Ultra-widefield (UWF) fundus image; 200-degree field of view.
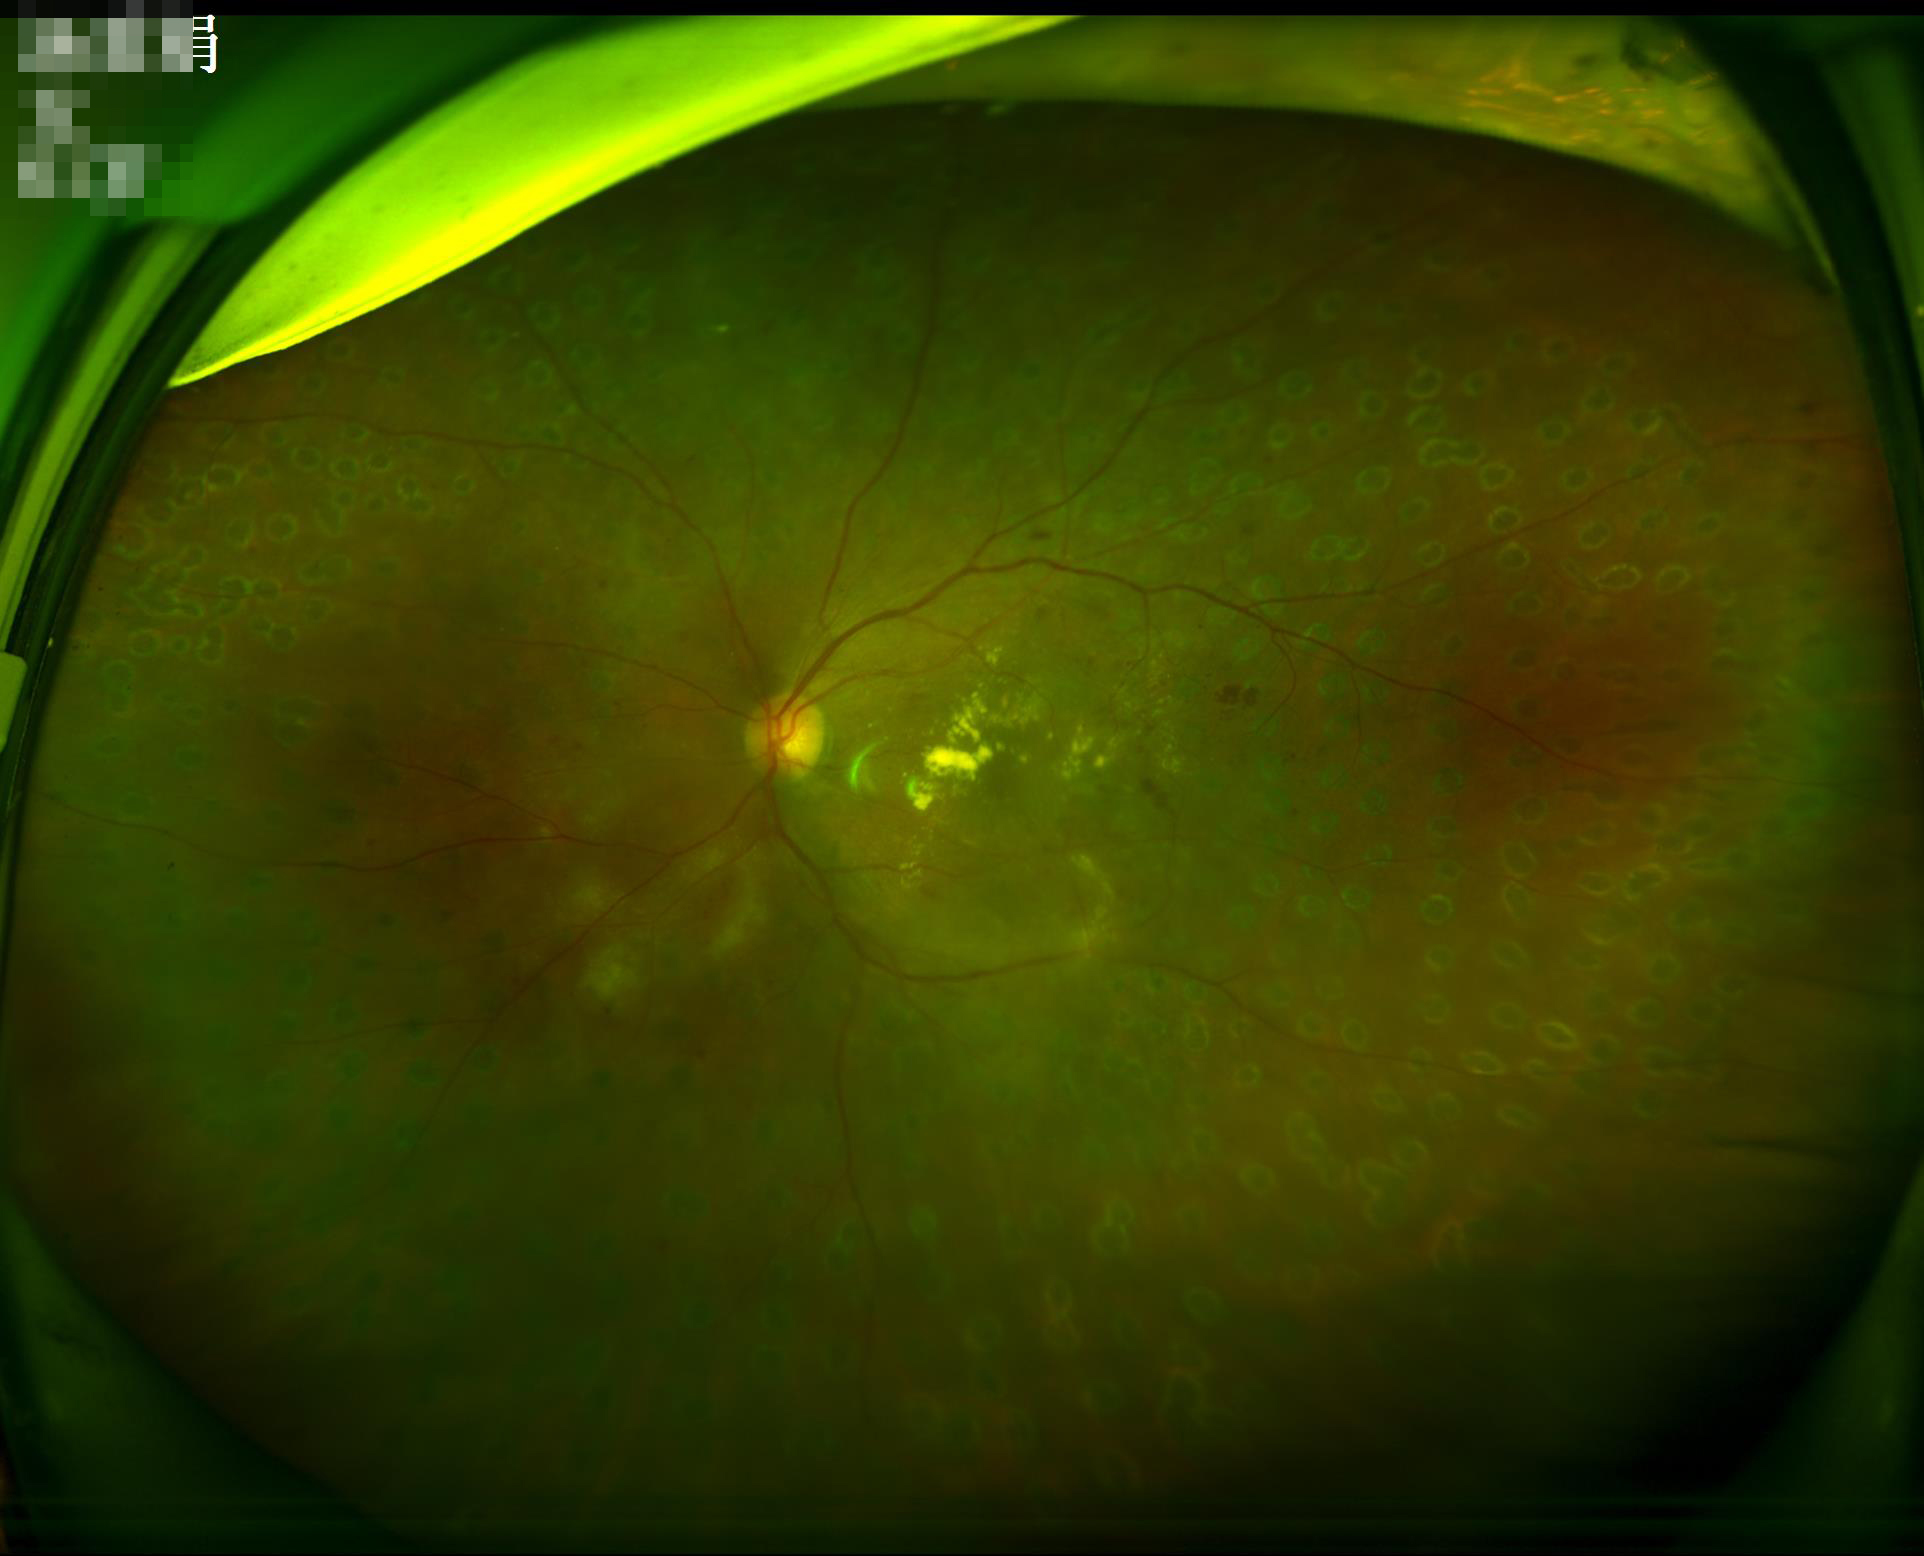

Contrast is good. Overall quality is good and the image is gradable.